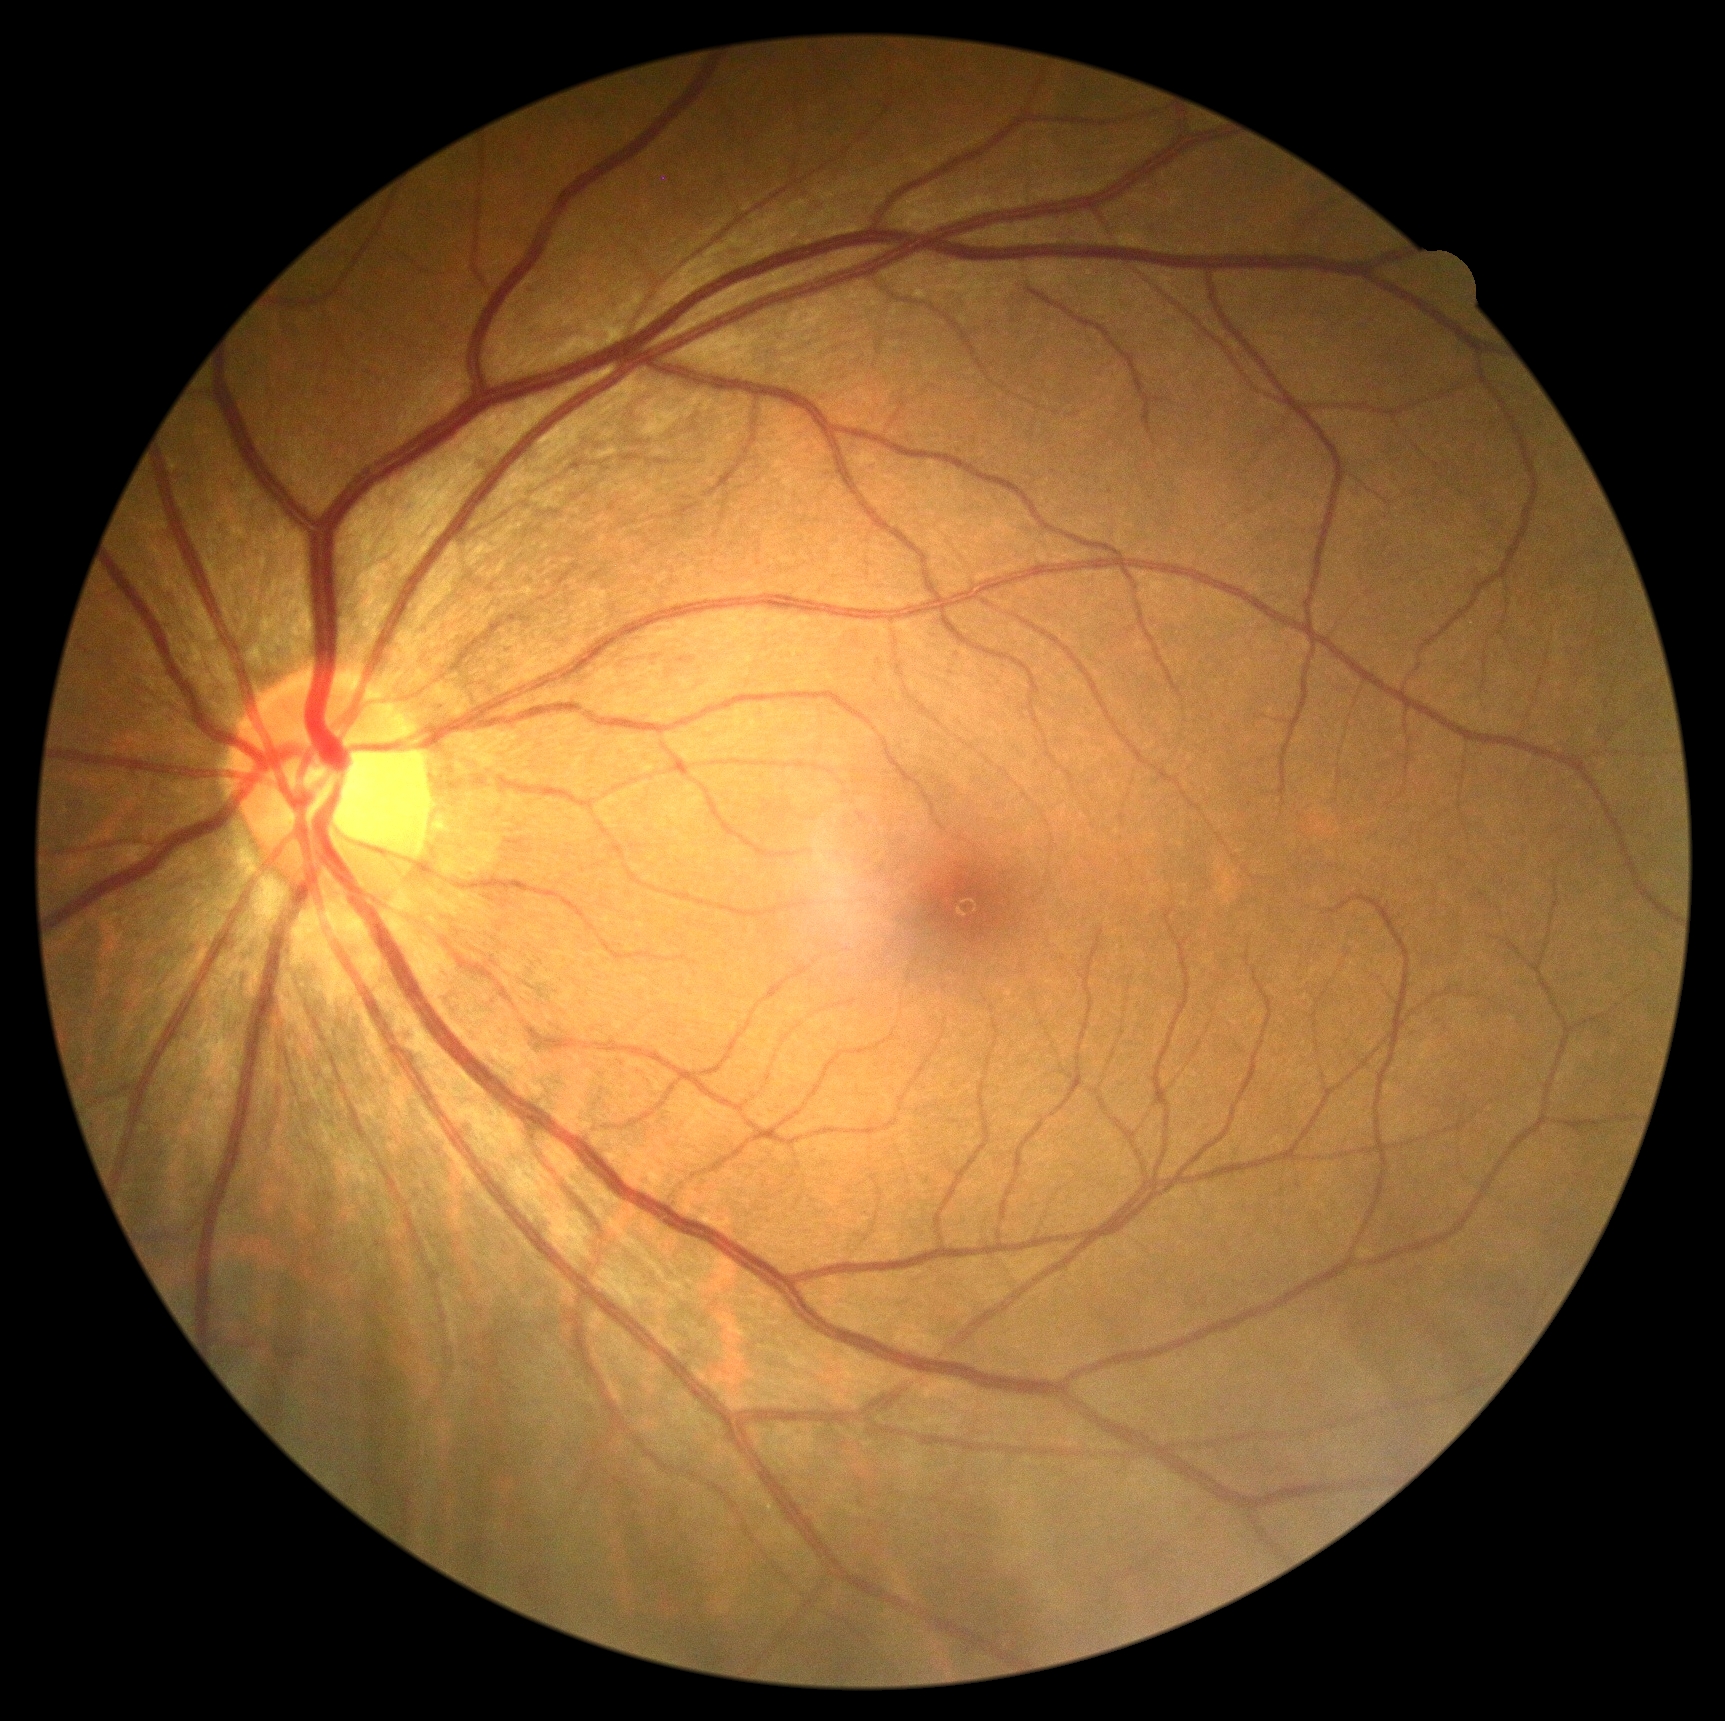
{"dr_grade": "no apparent diabetic retinopathy (0)"}